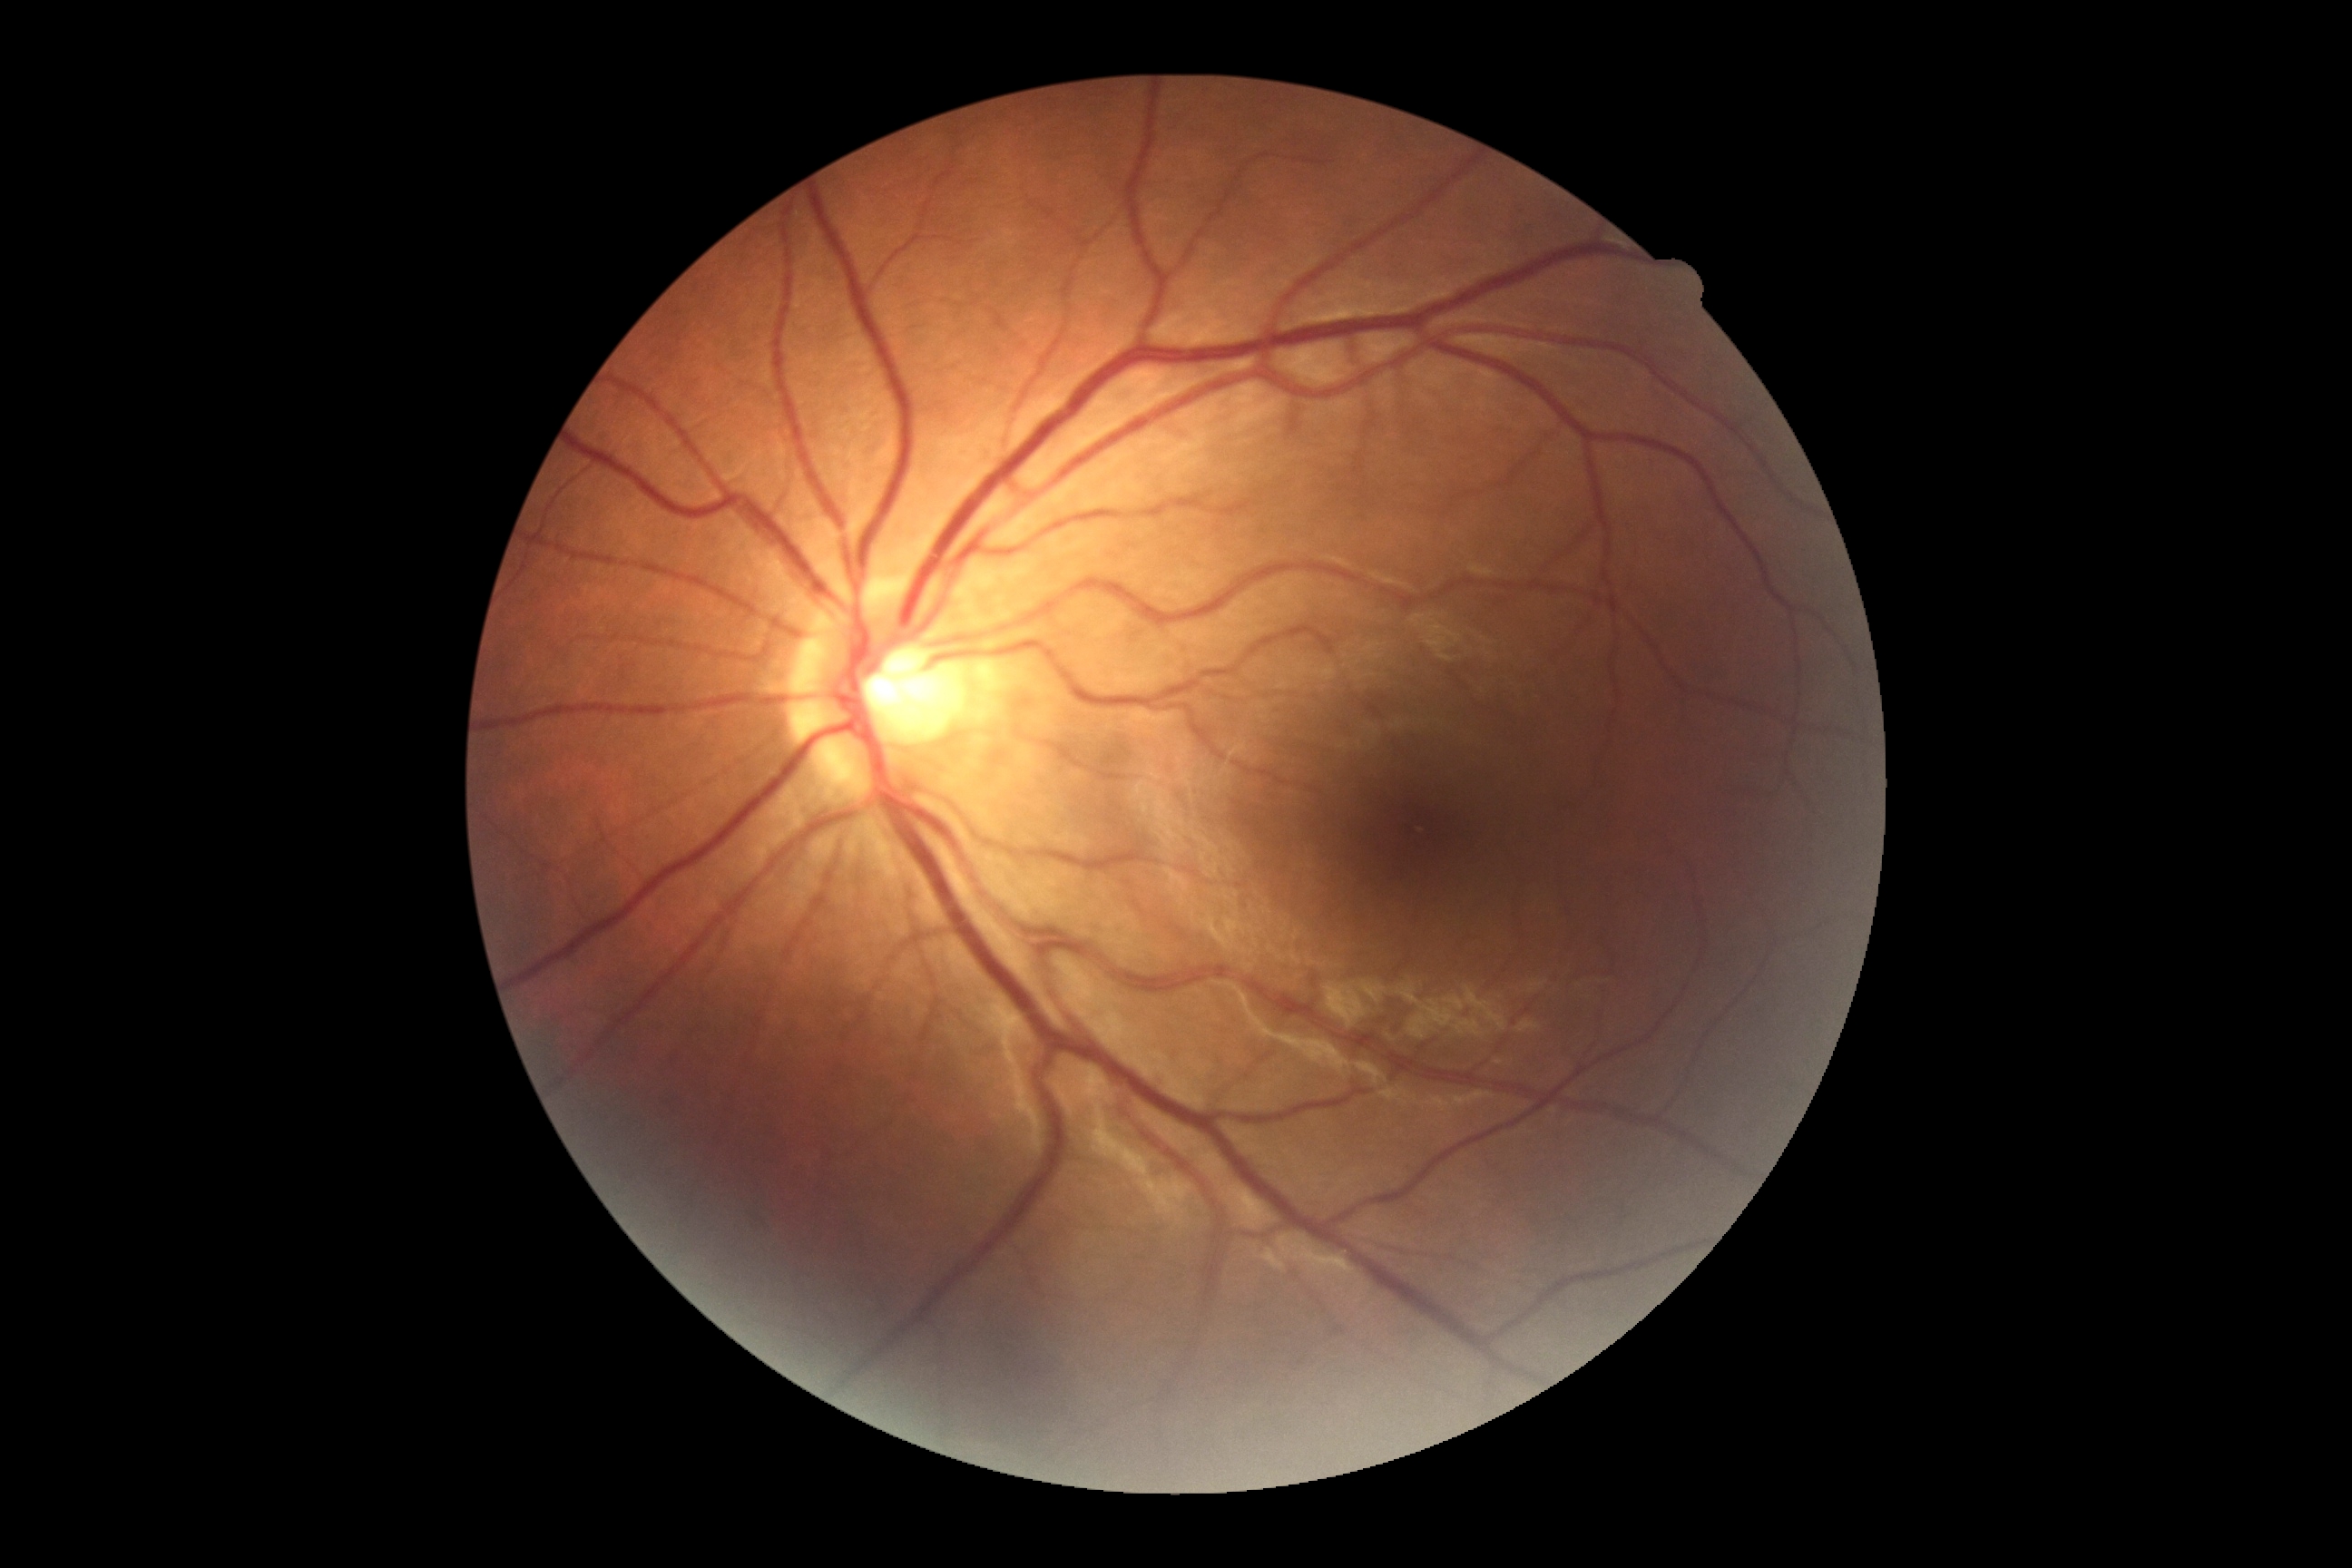
Diabetic retinopathy severity is grade 0 (no apparent retinopathy).
No signs of diabetic retinopathy.